Pediatric retinal photograph (wide-field).
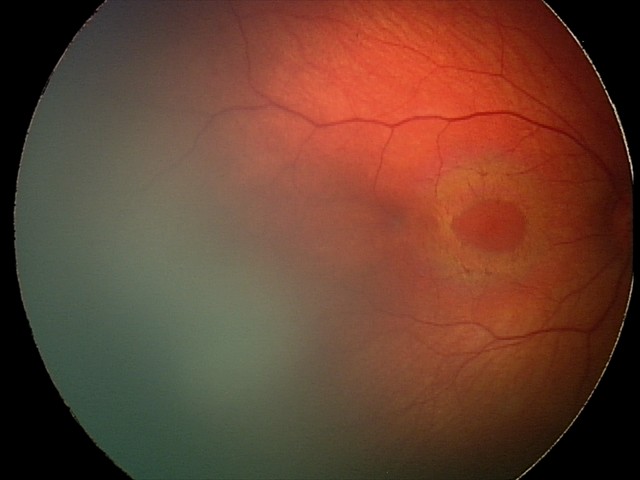

Series diagnosed as retinal hemorrhages.